Tabletop color fundus camera image · 412x310px:
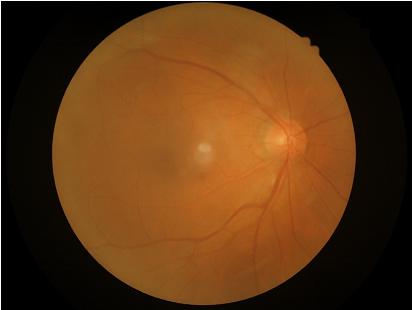
Quality assessment:
- overall: good
- contrast: adequate
- focus: sharp
- illumination: even